Davis DR grading.
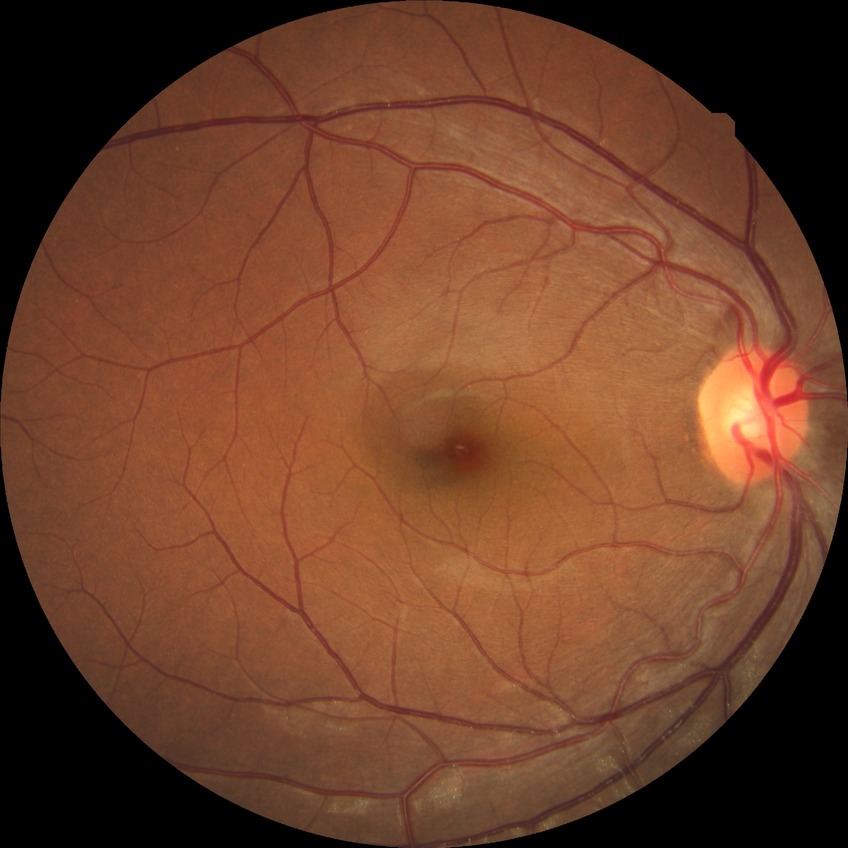 DR grade: NDR.